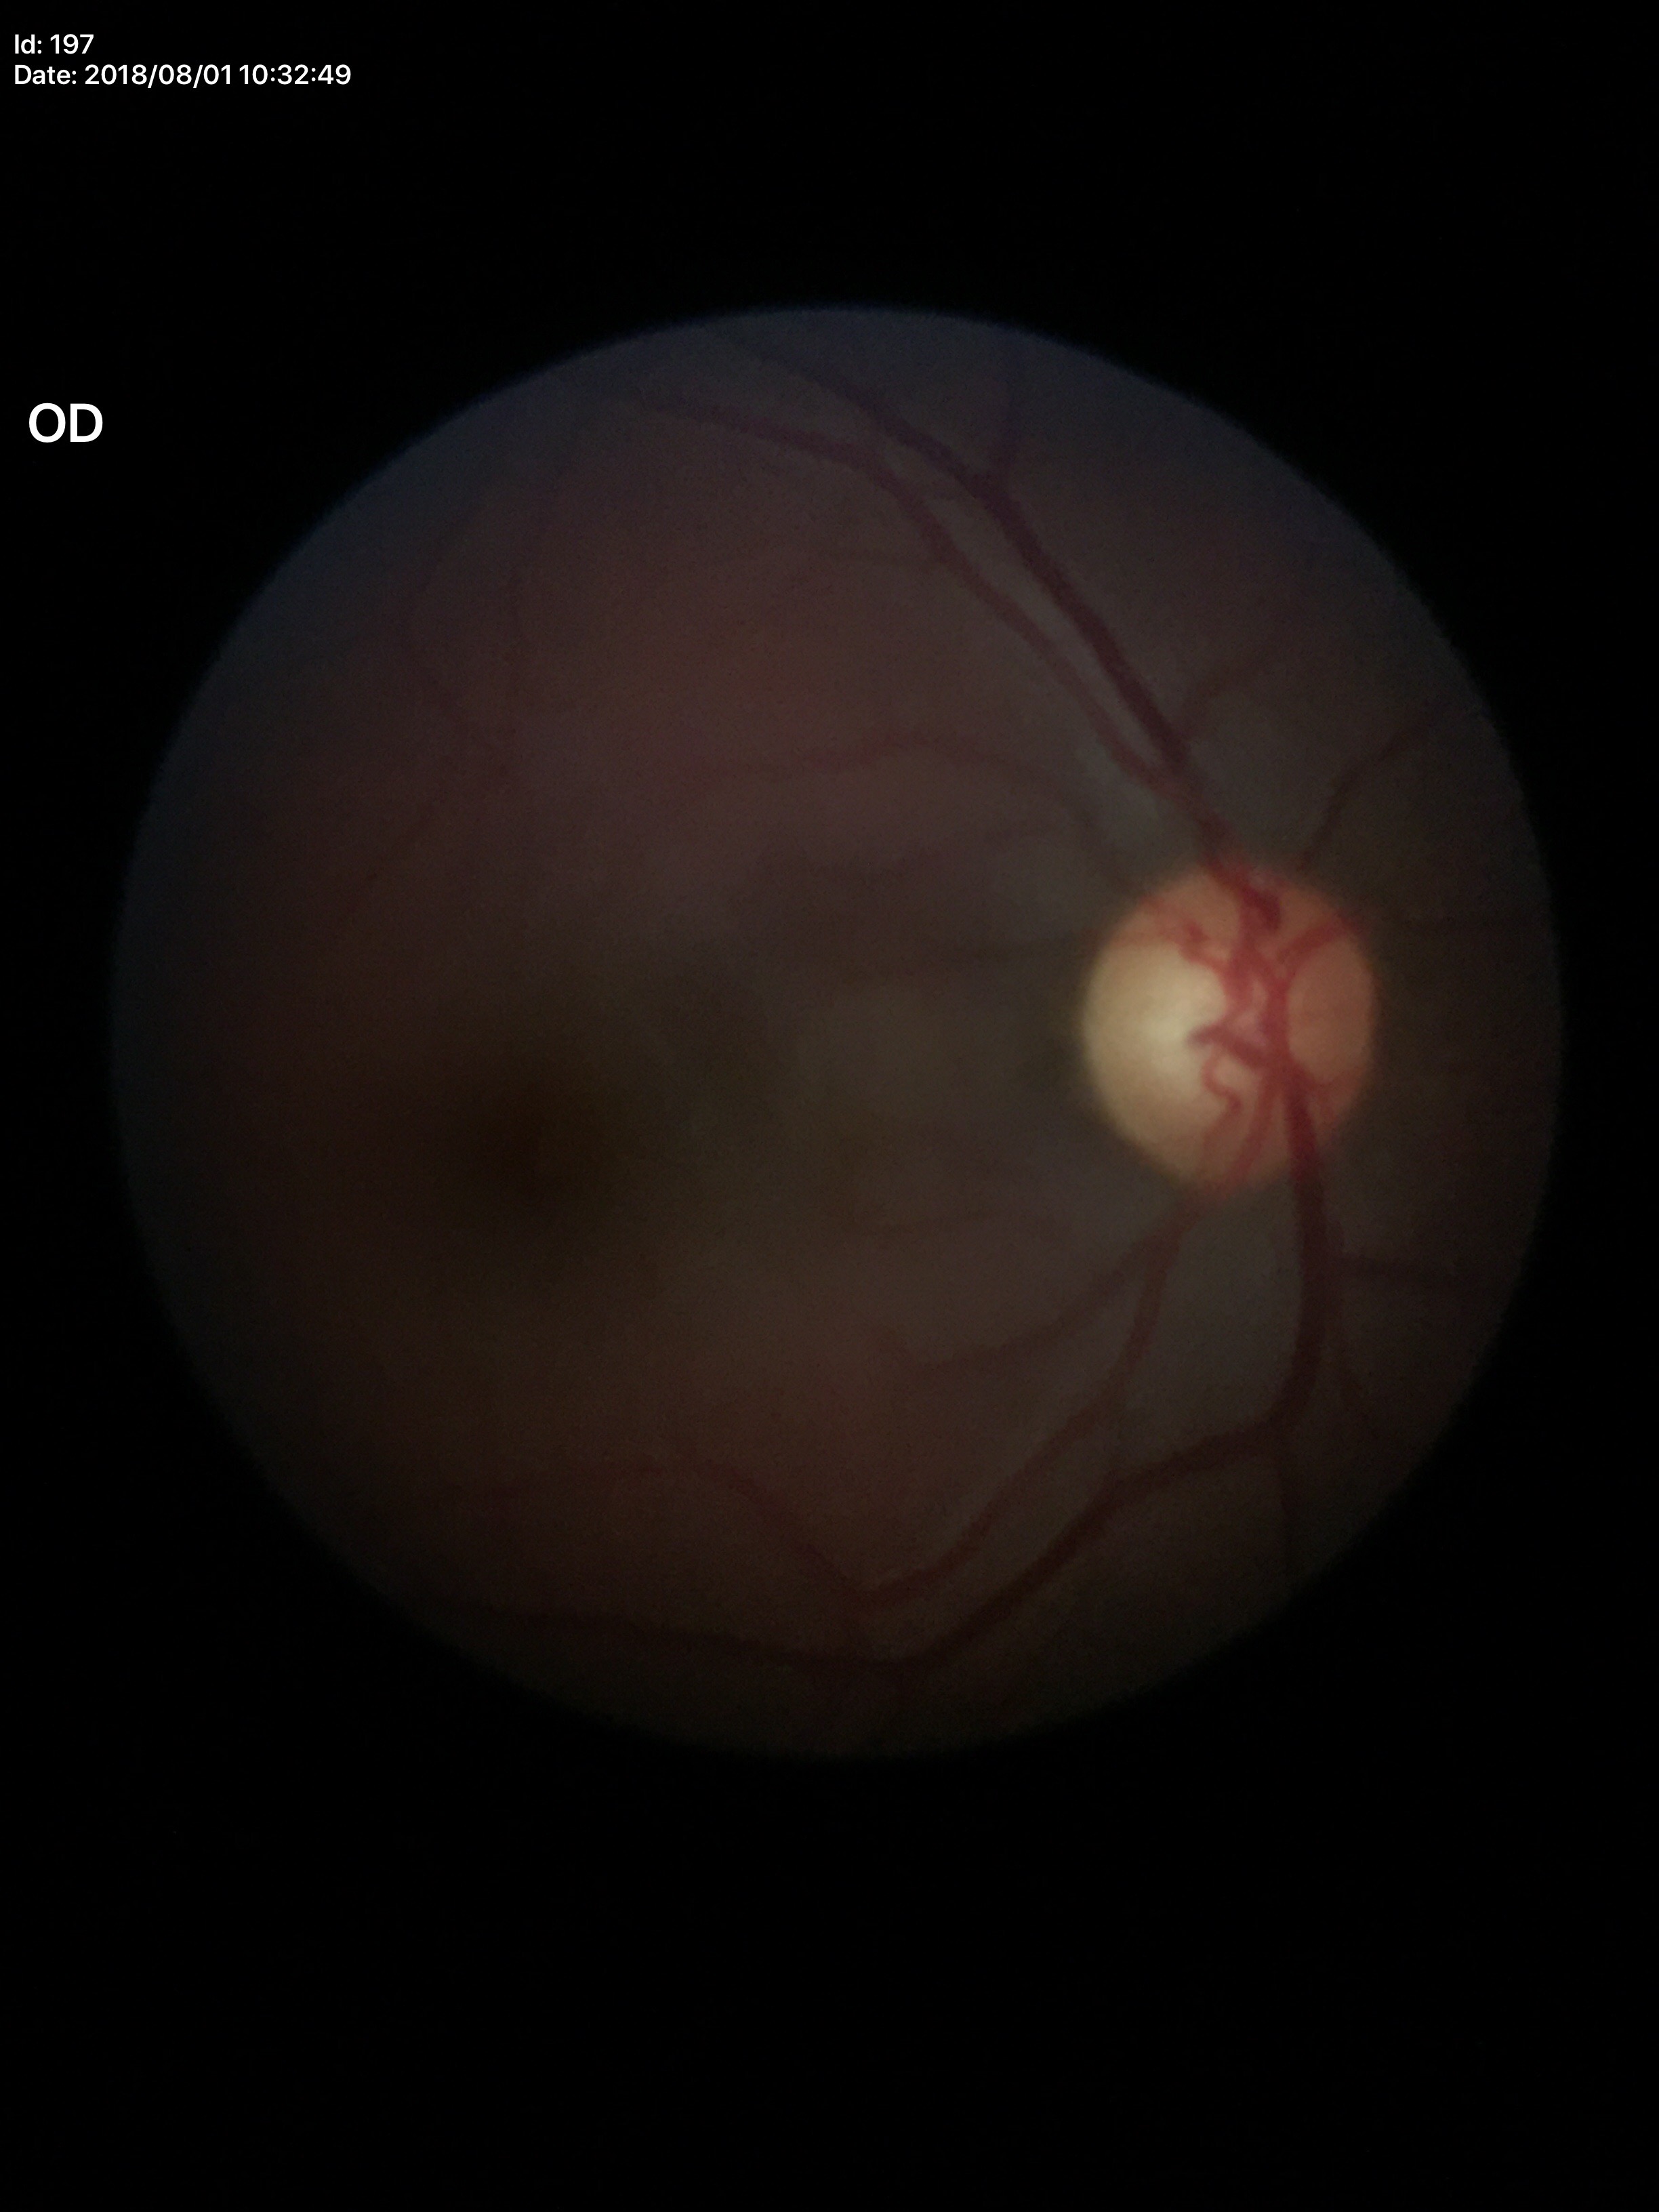

Vertical CDR (VCDR) is 0.57.
Horizontal cup-disc ratio (HCDR) of 0.55.
Glaucoma assessment: negative.